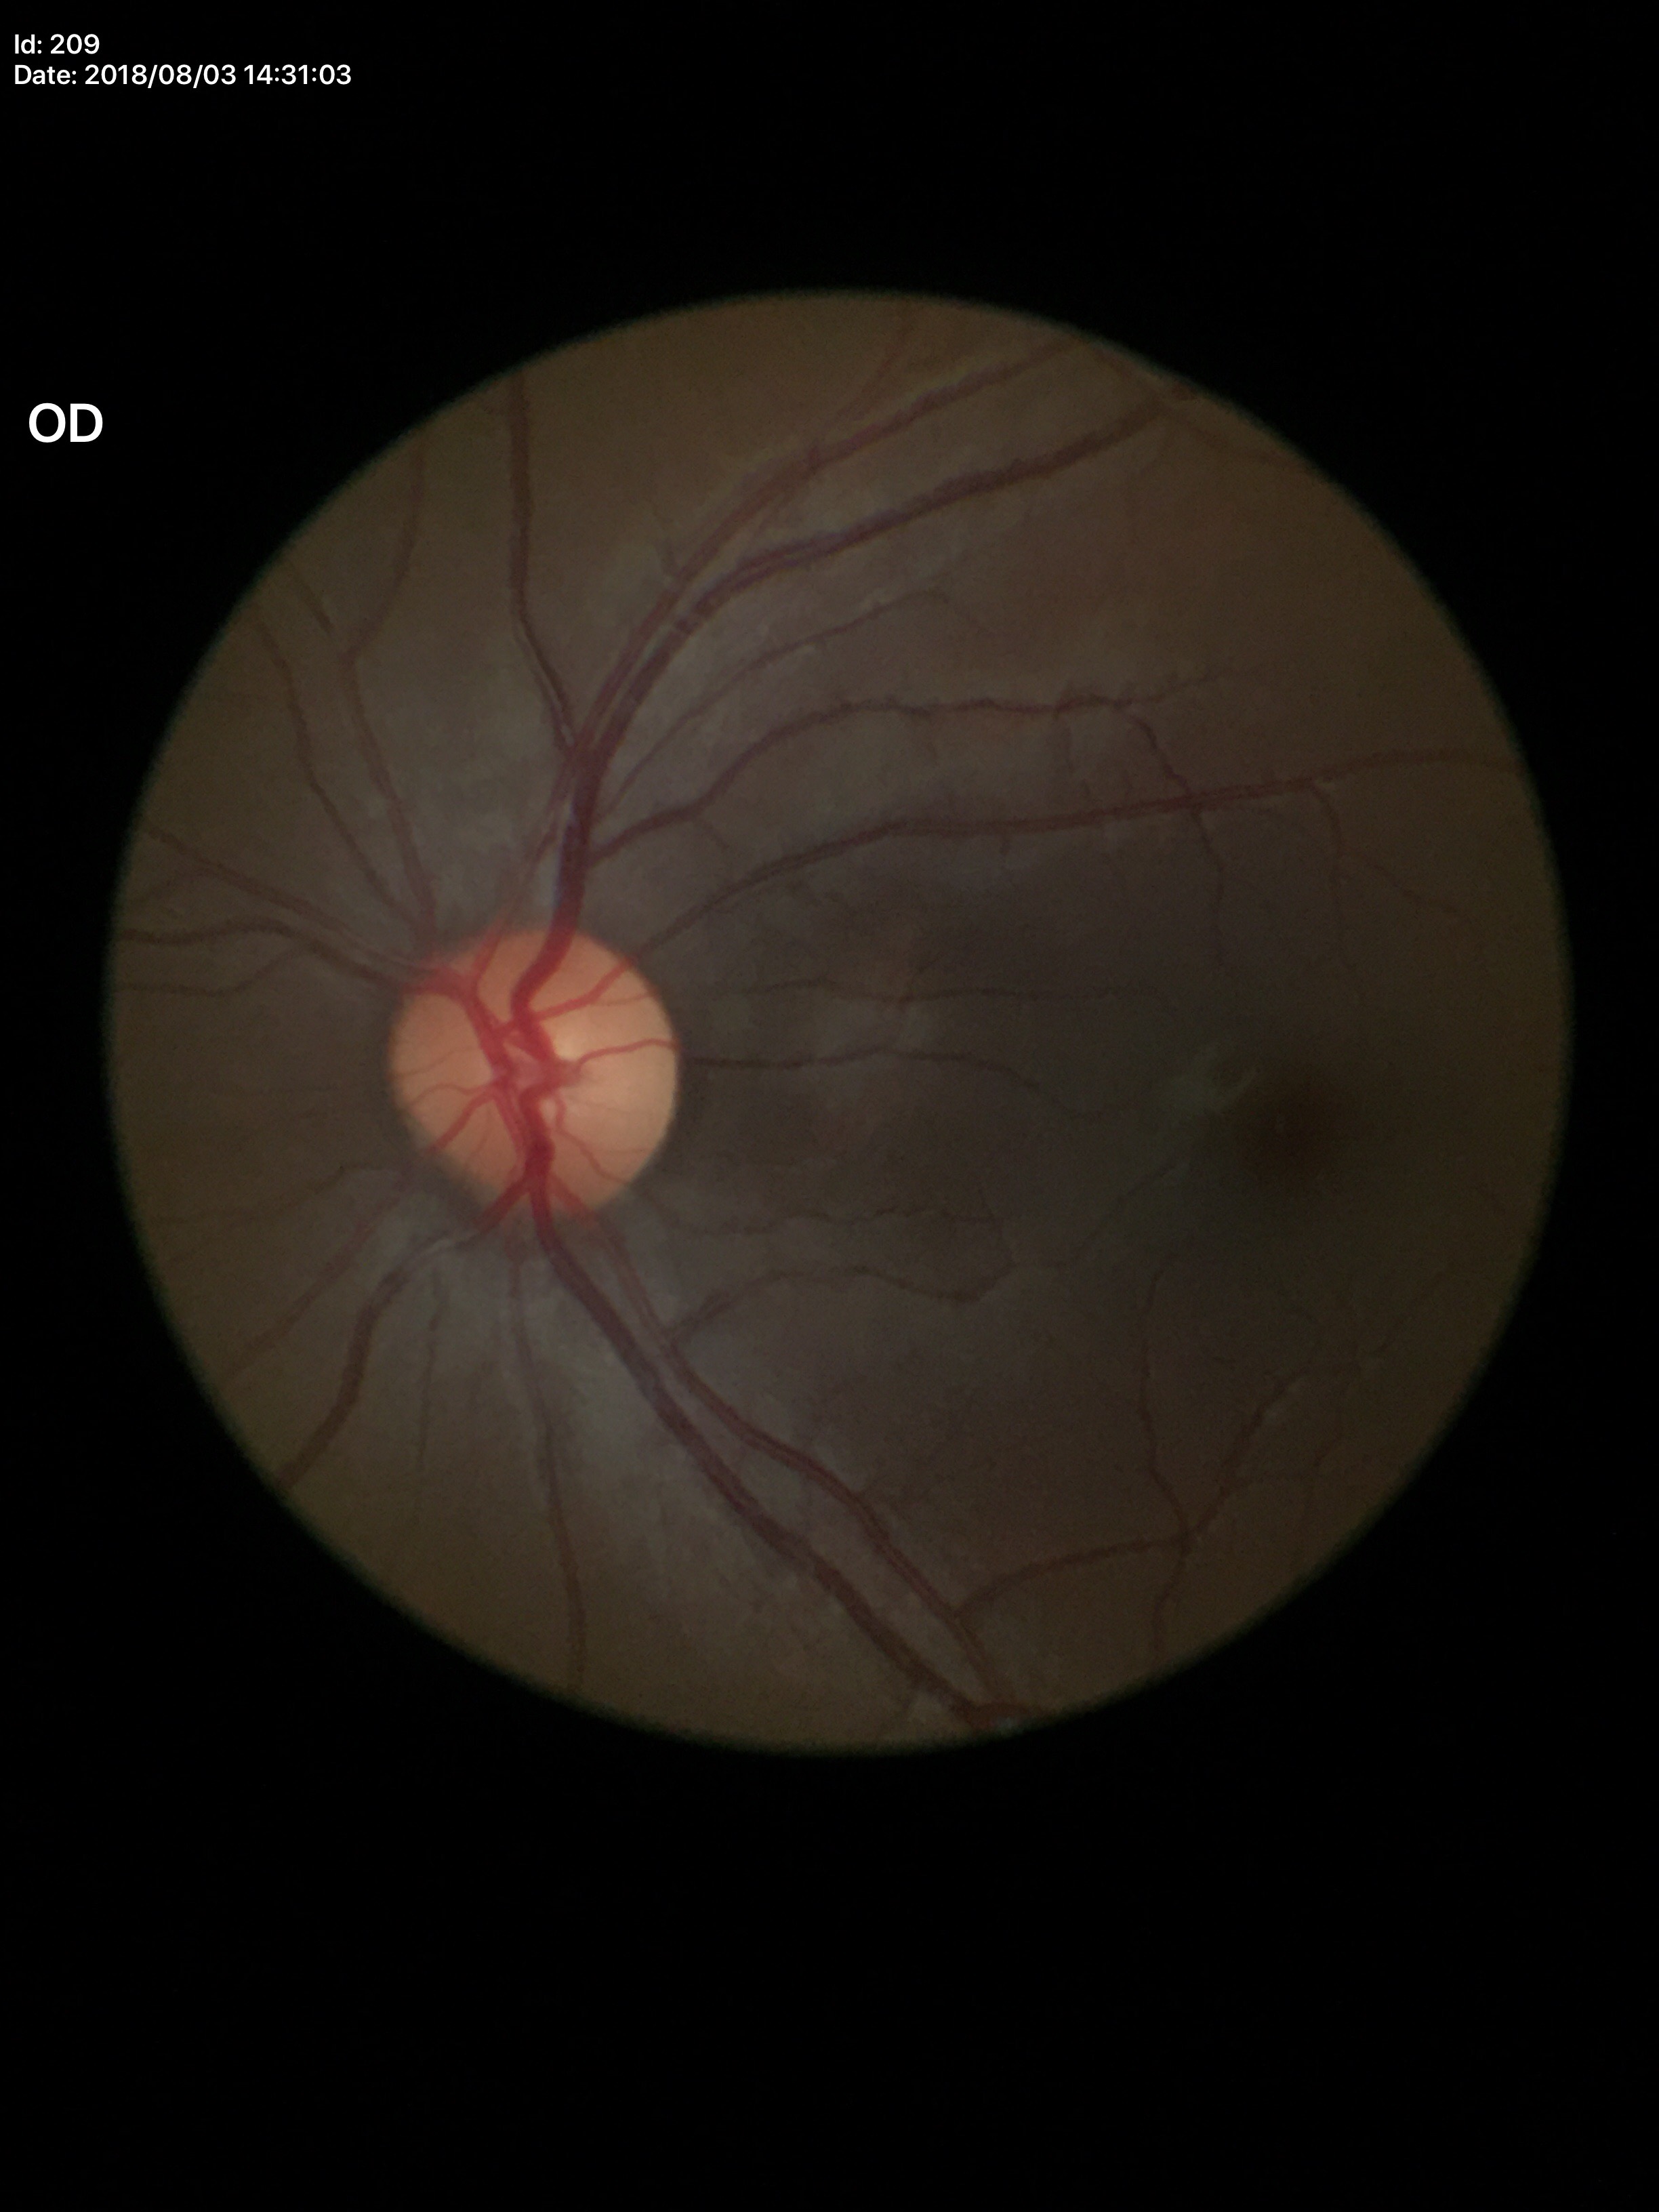   glaucoma_decision: not suspect
  vcdr: 0.42
  hcdr: 0.42
  acdr: 0.18